640 x 480 pixels. 130° field of view (Clarity RetCam 3). Infant wide-field fundus photograph:
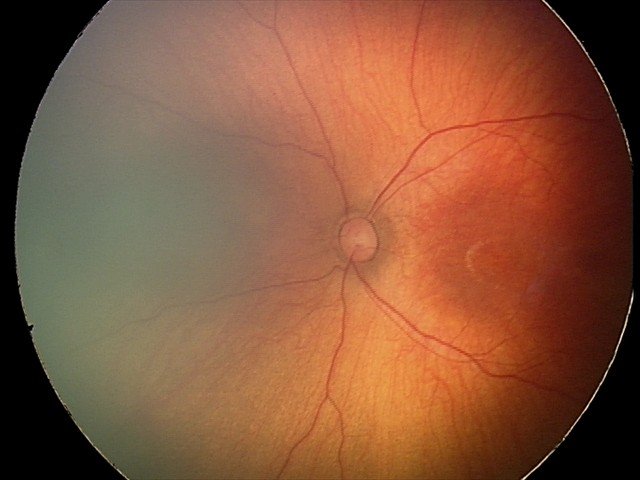 Normal screening examination.